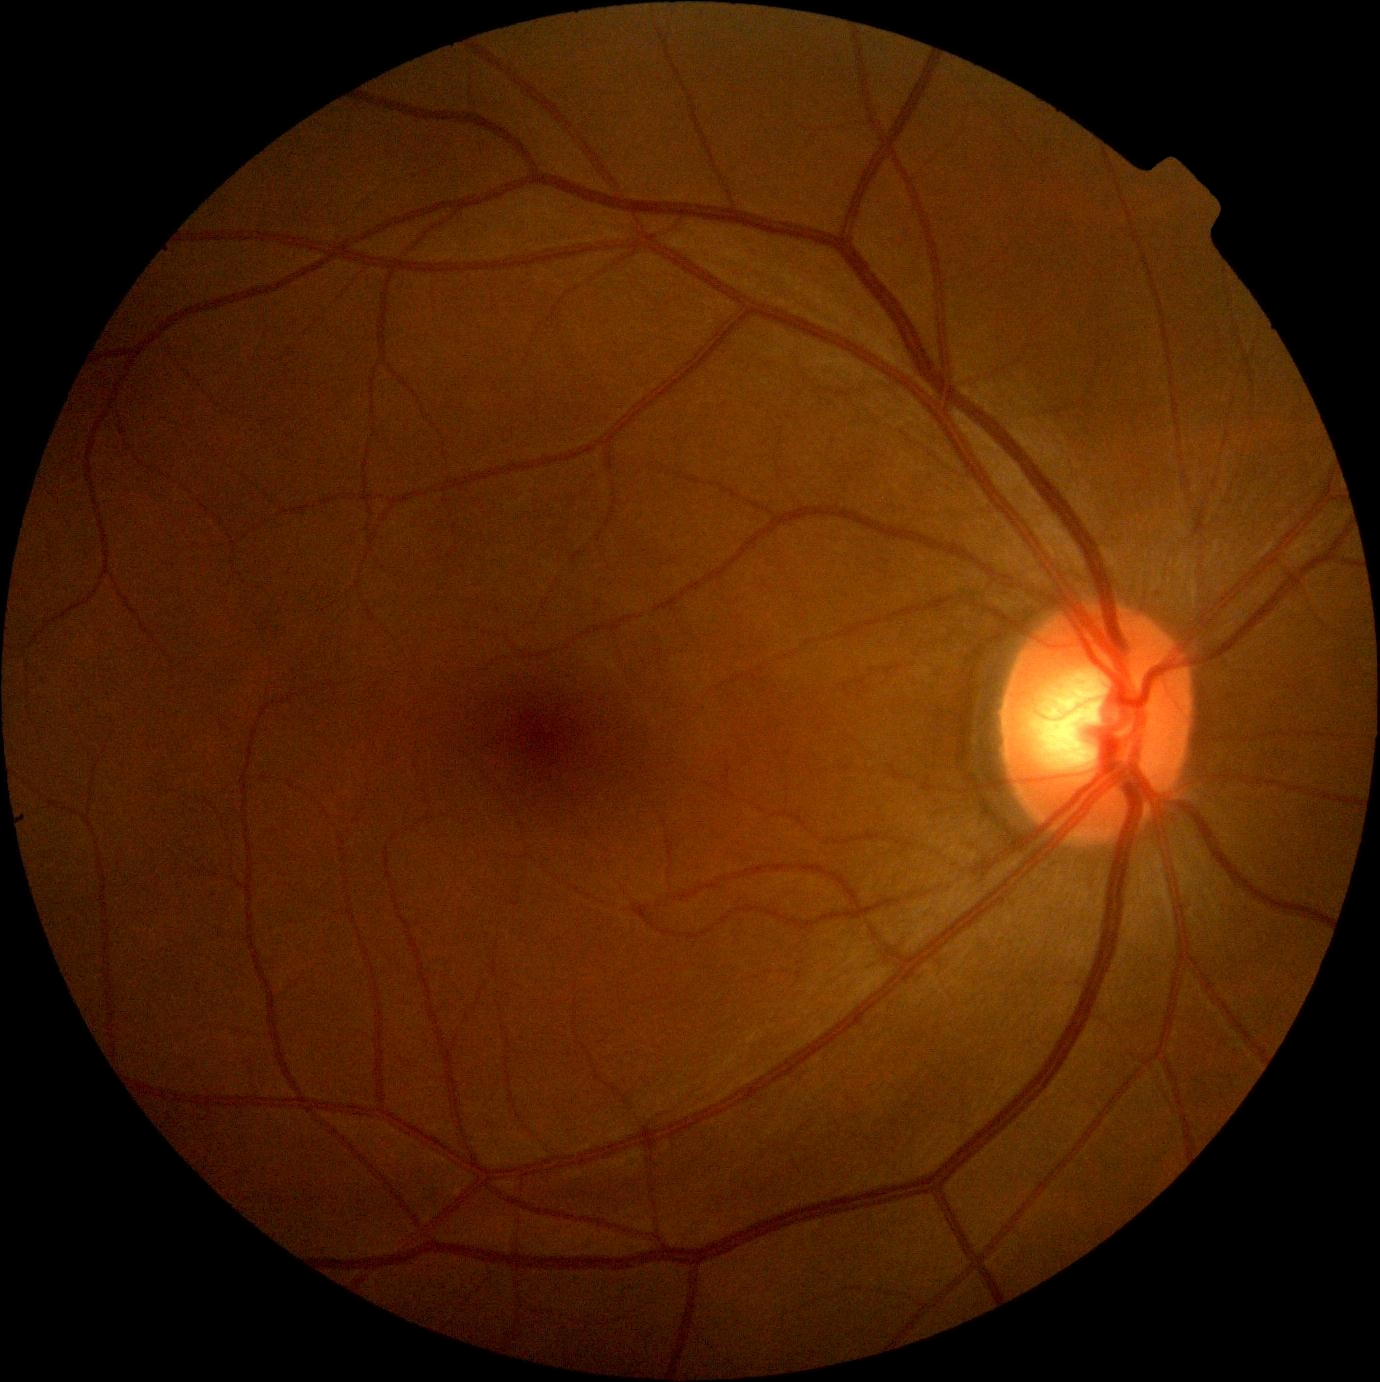
{
  "dr_grade": "no apparent retinopathy (grade 0) — no visible signs of diabetic retinopathy"
}